45-degree field of view:
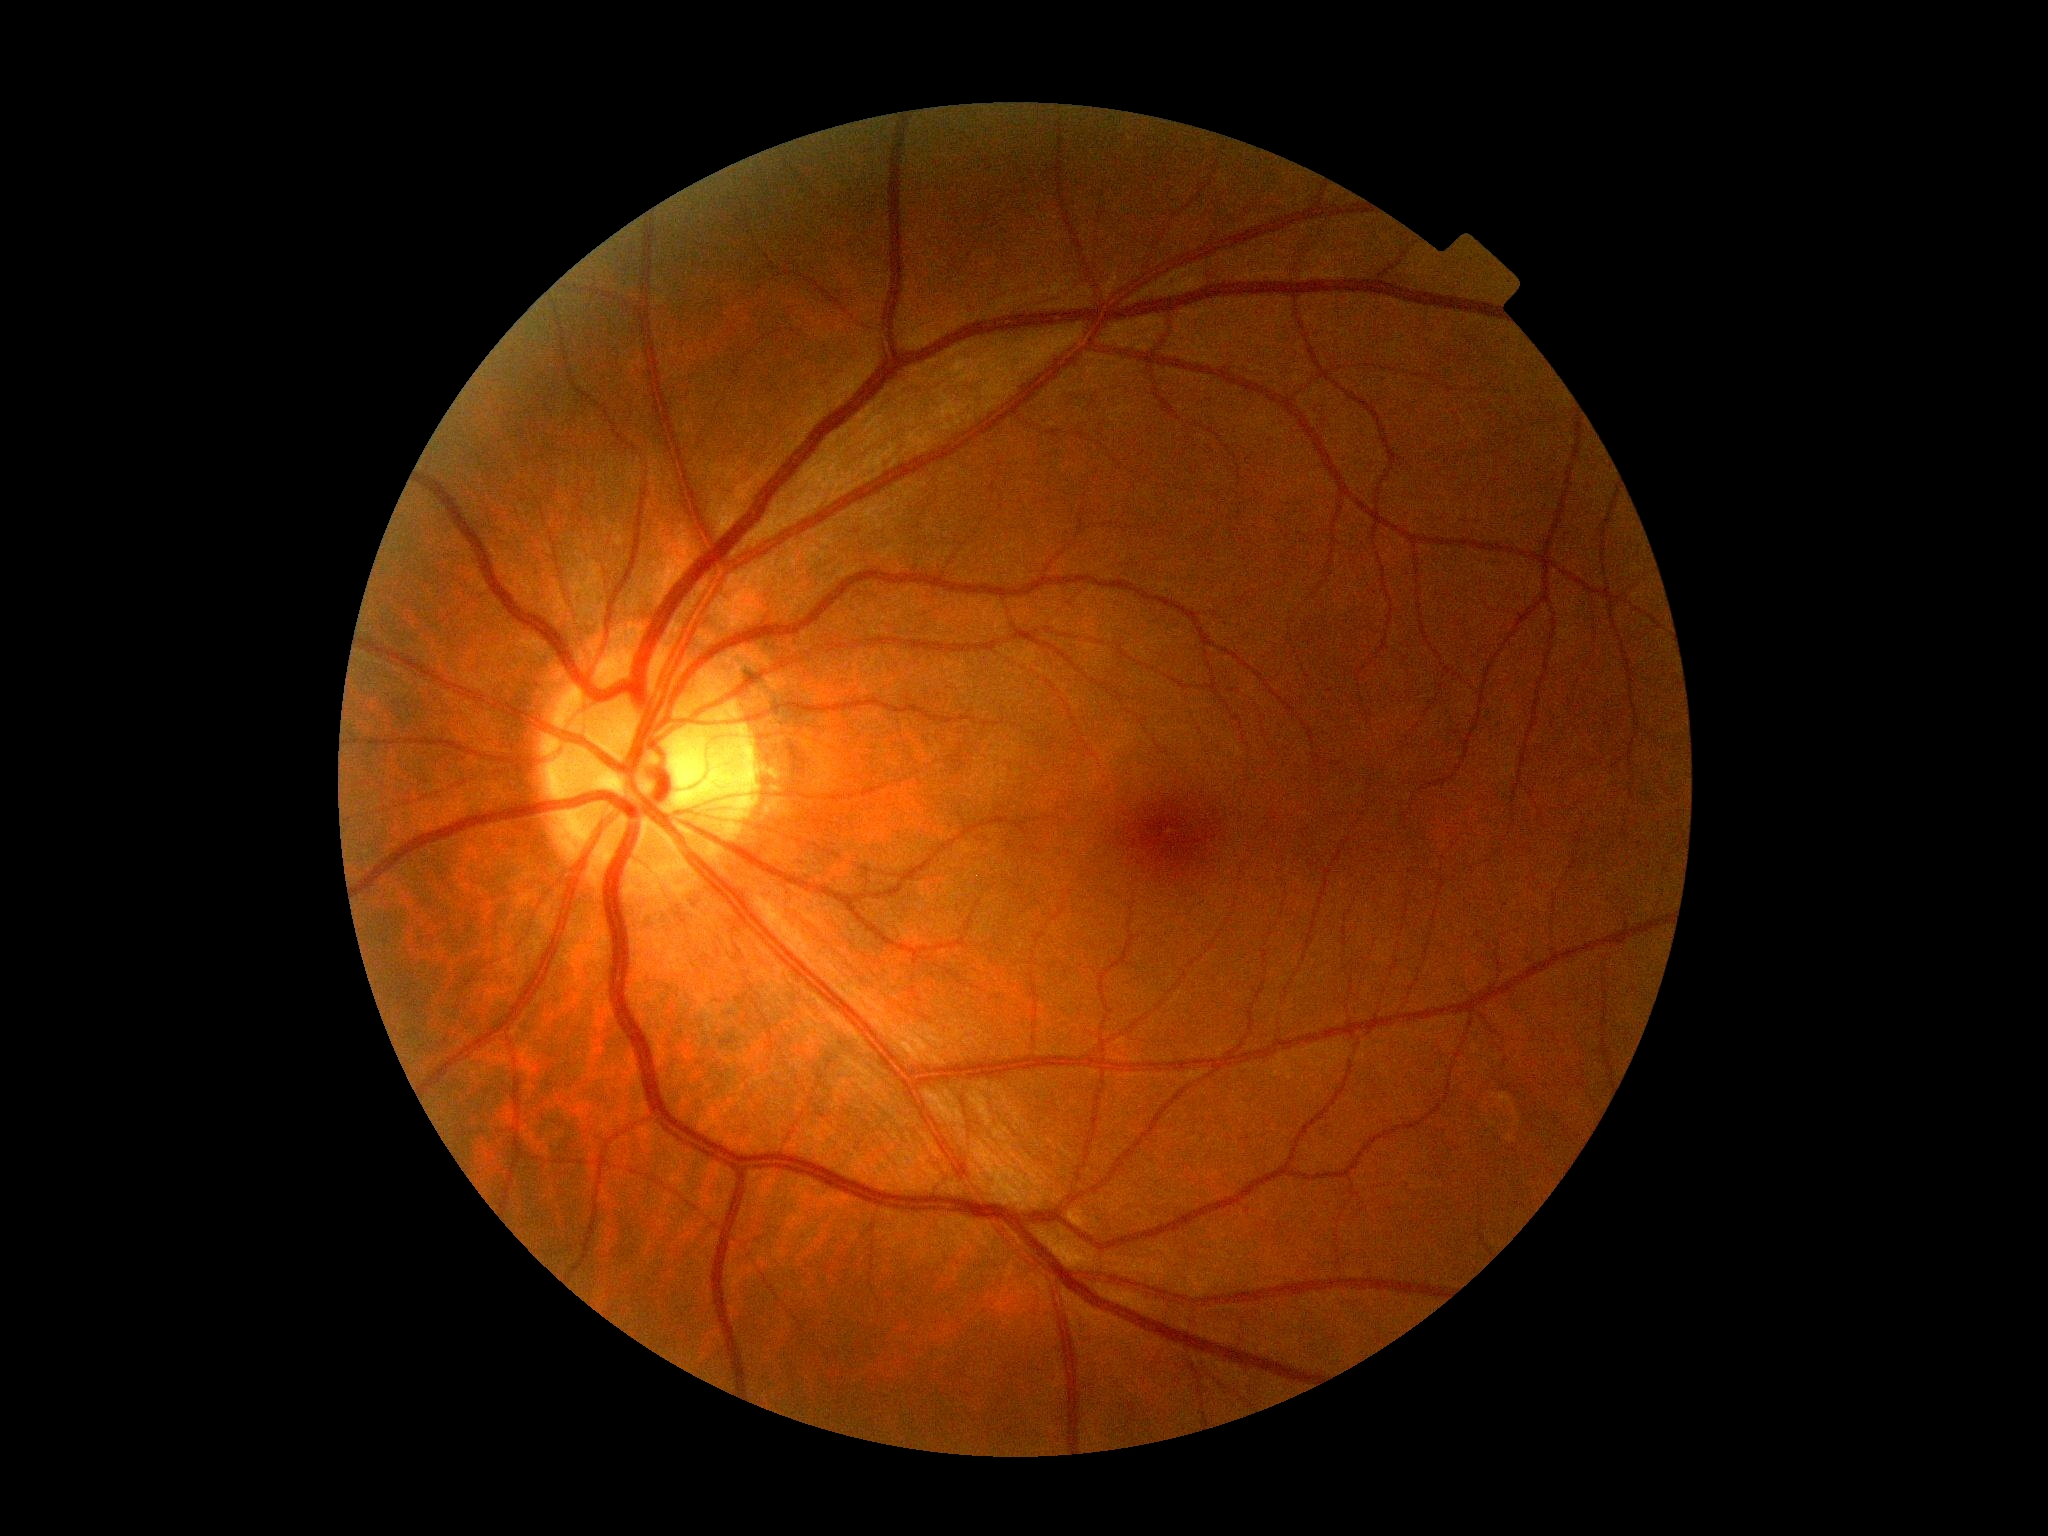 {
  "dr_grade": "0"
}